2352x1568 · 45° field of view · color fundus image
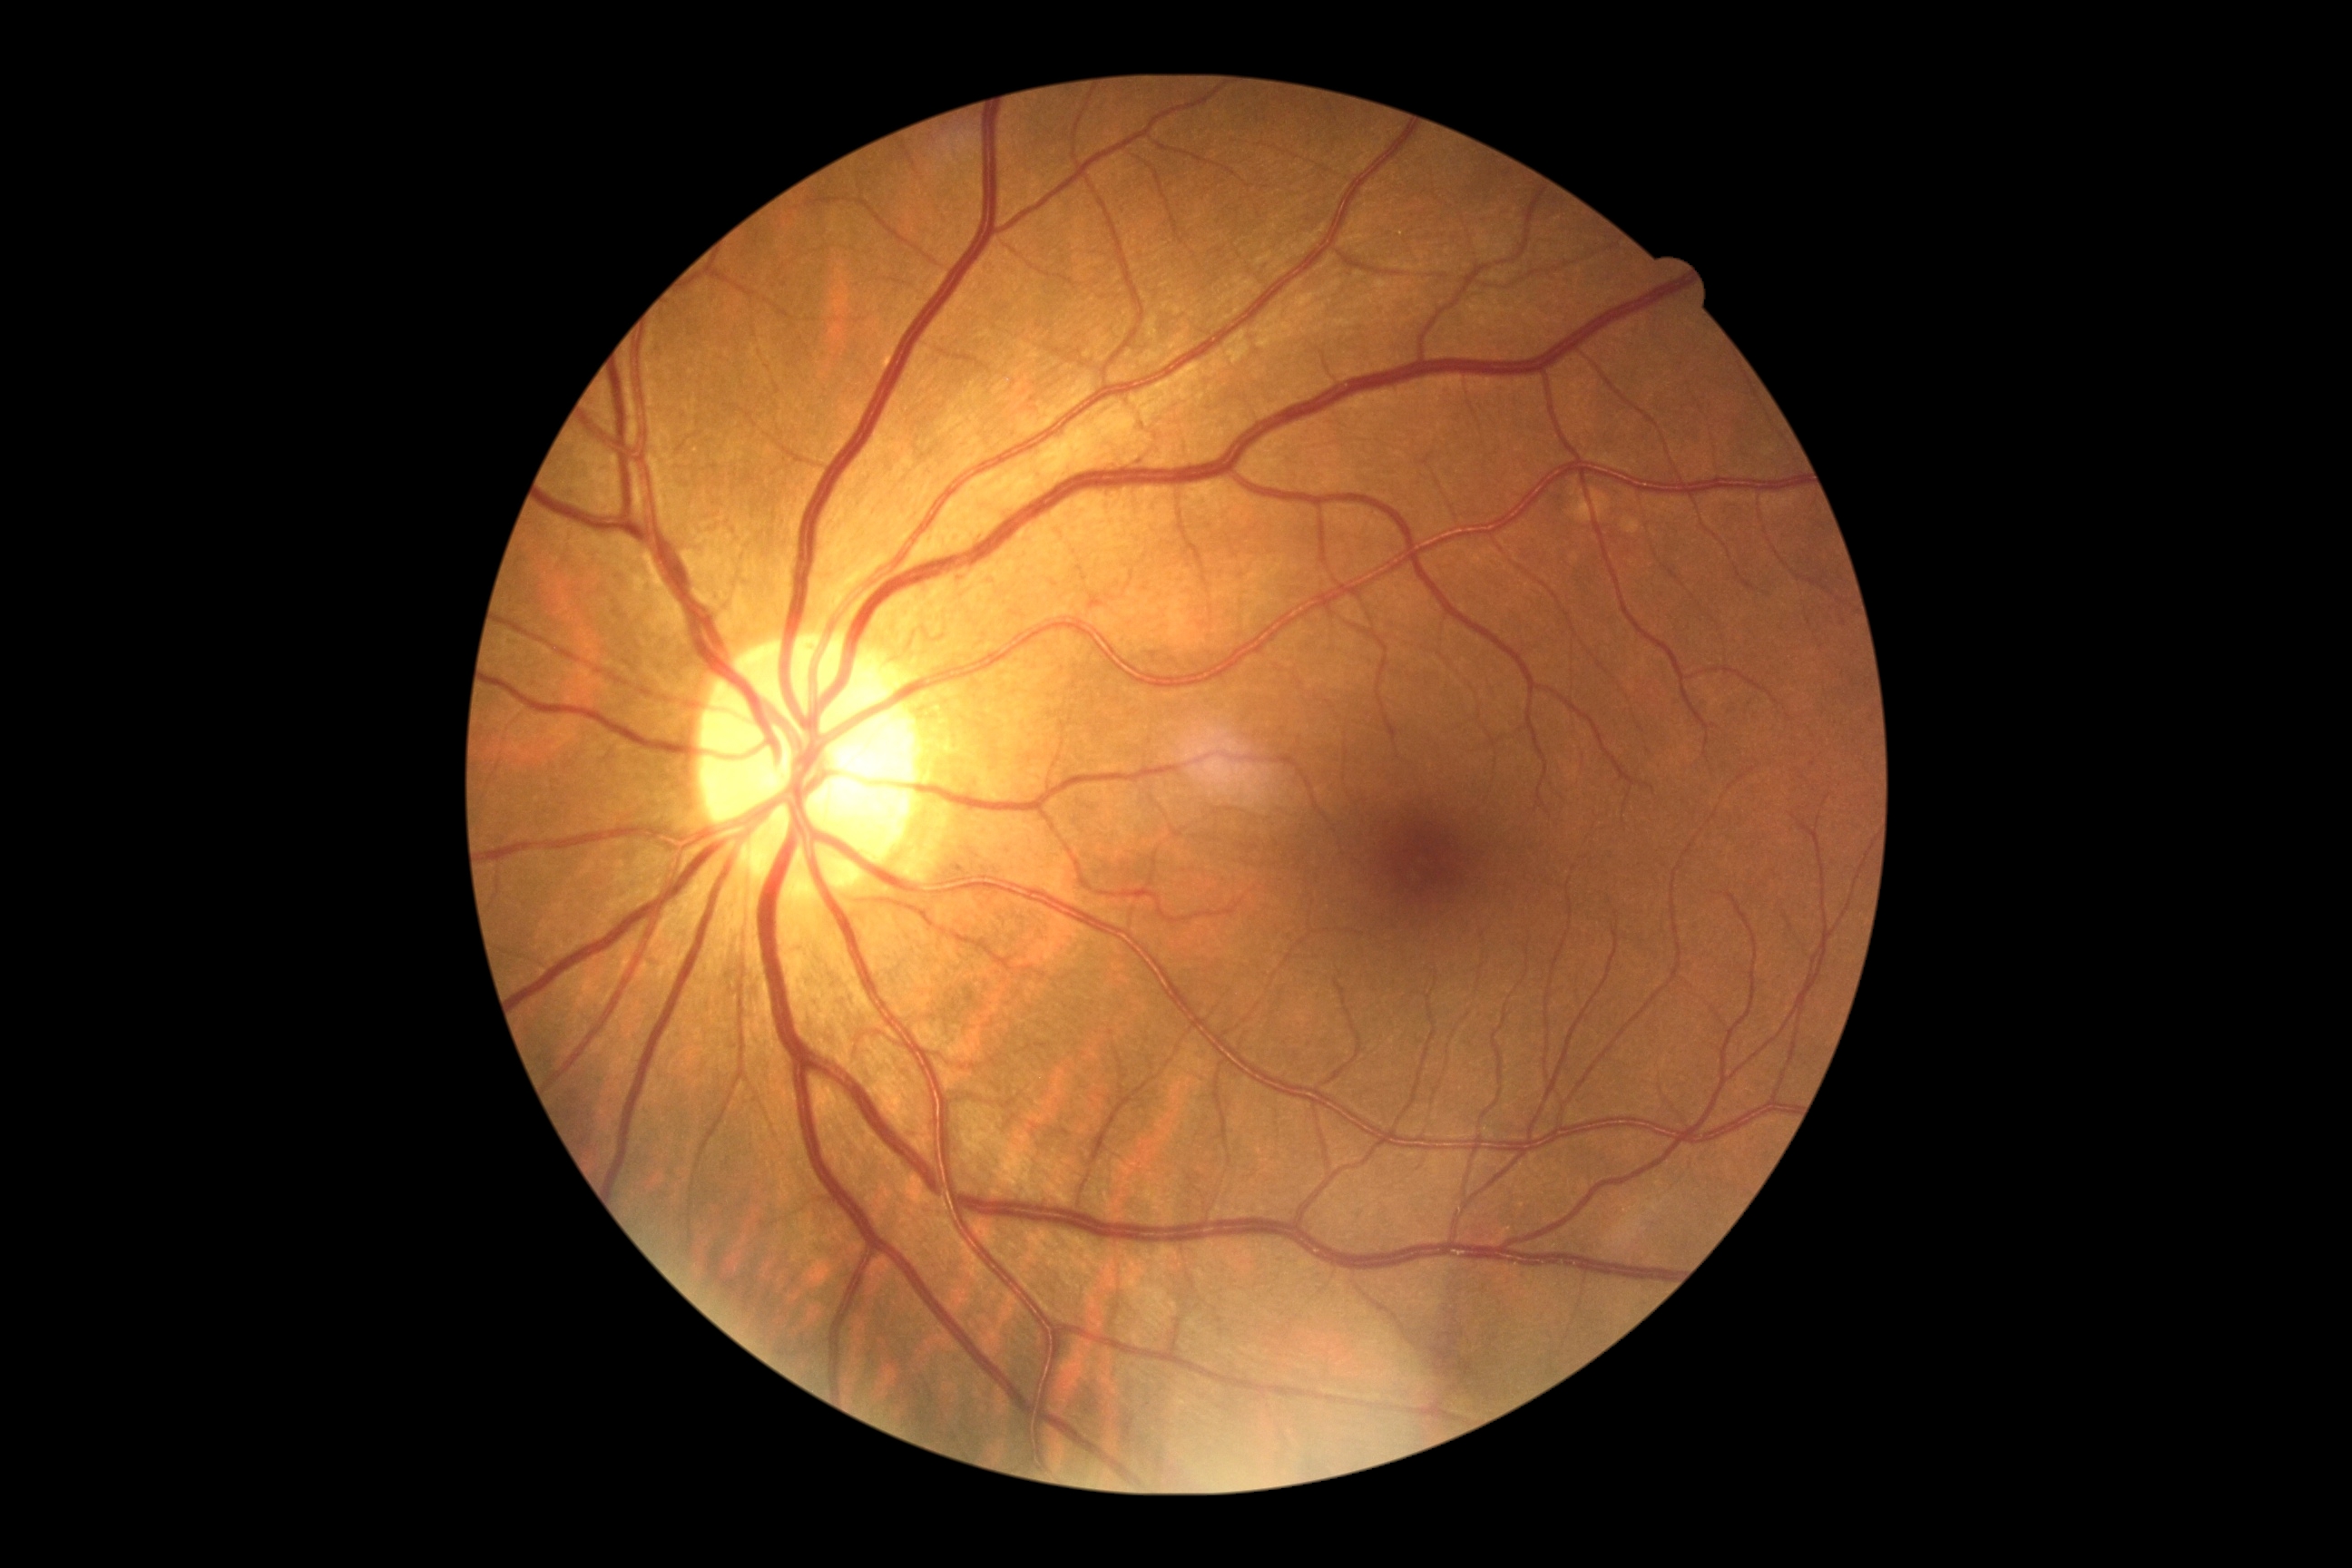
diabetic retinopathy (DR): no apparent diabetic retinopathy (grade 0) | DR impression: no DR findings.